2048x1536 · 45-degree field of view.
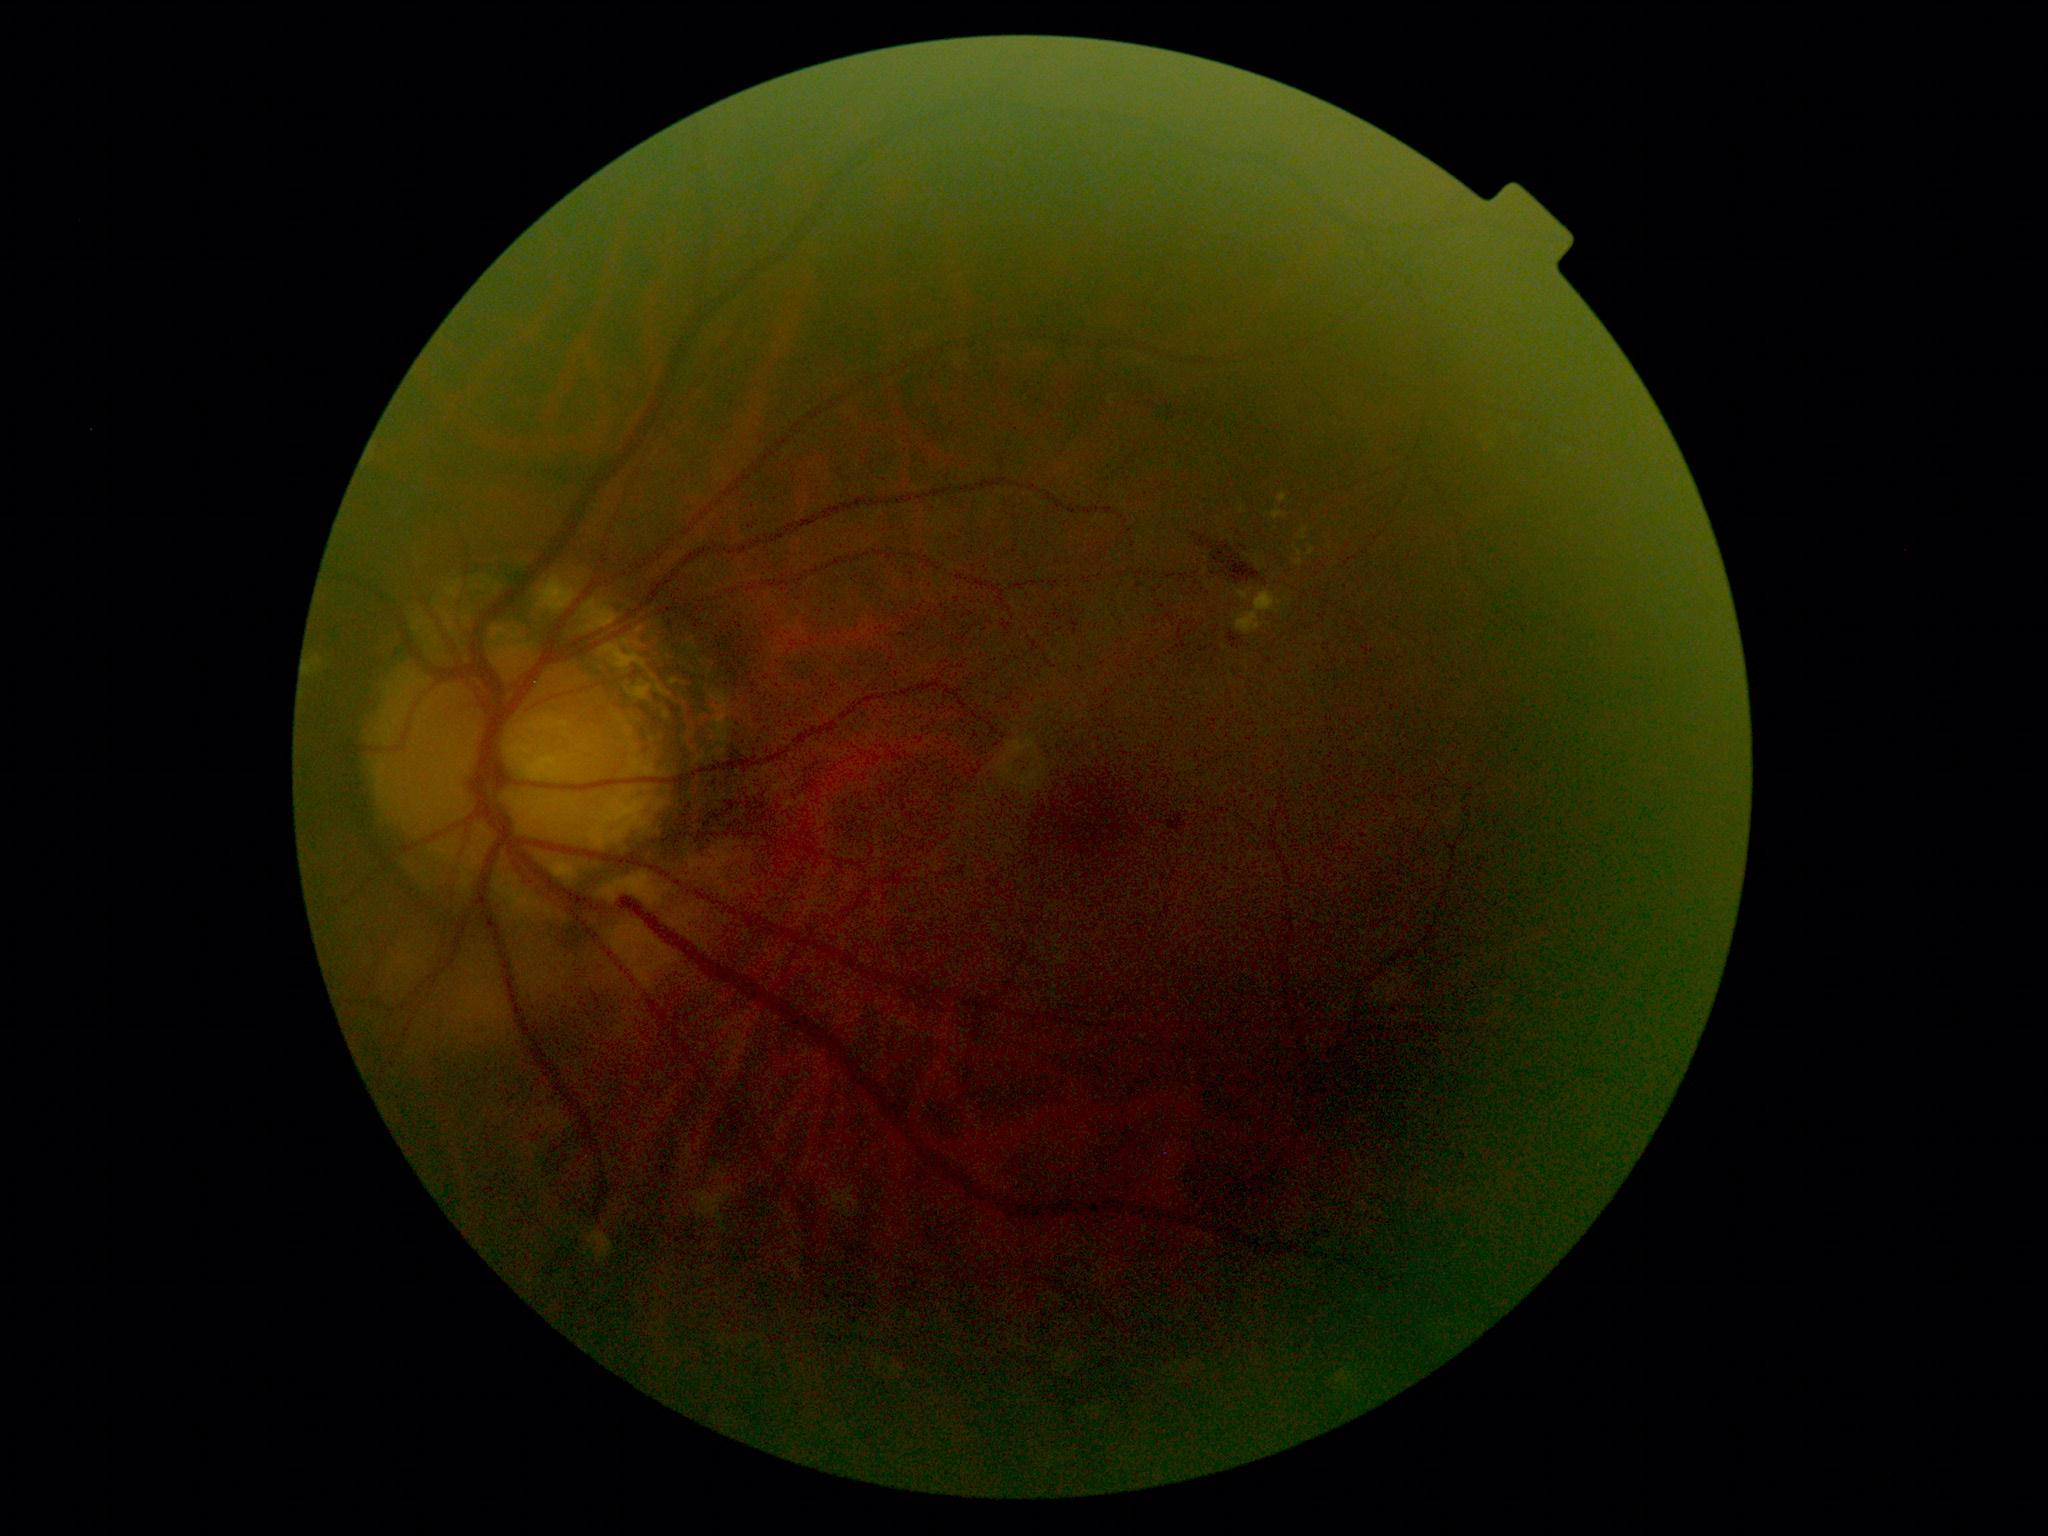
DR severity is grade 2 (moderate NPDR).